FOV: 45 degrees. 2352 x 1568 pixels
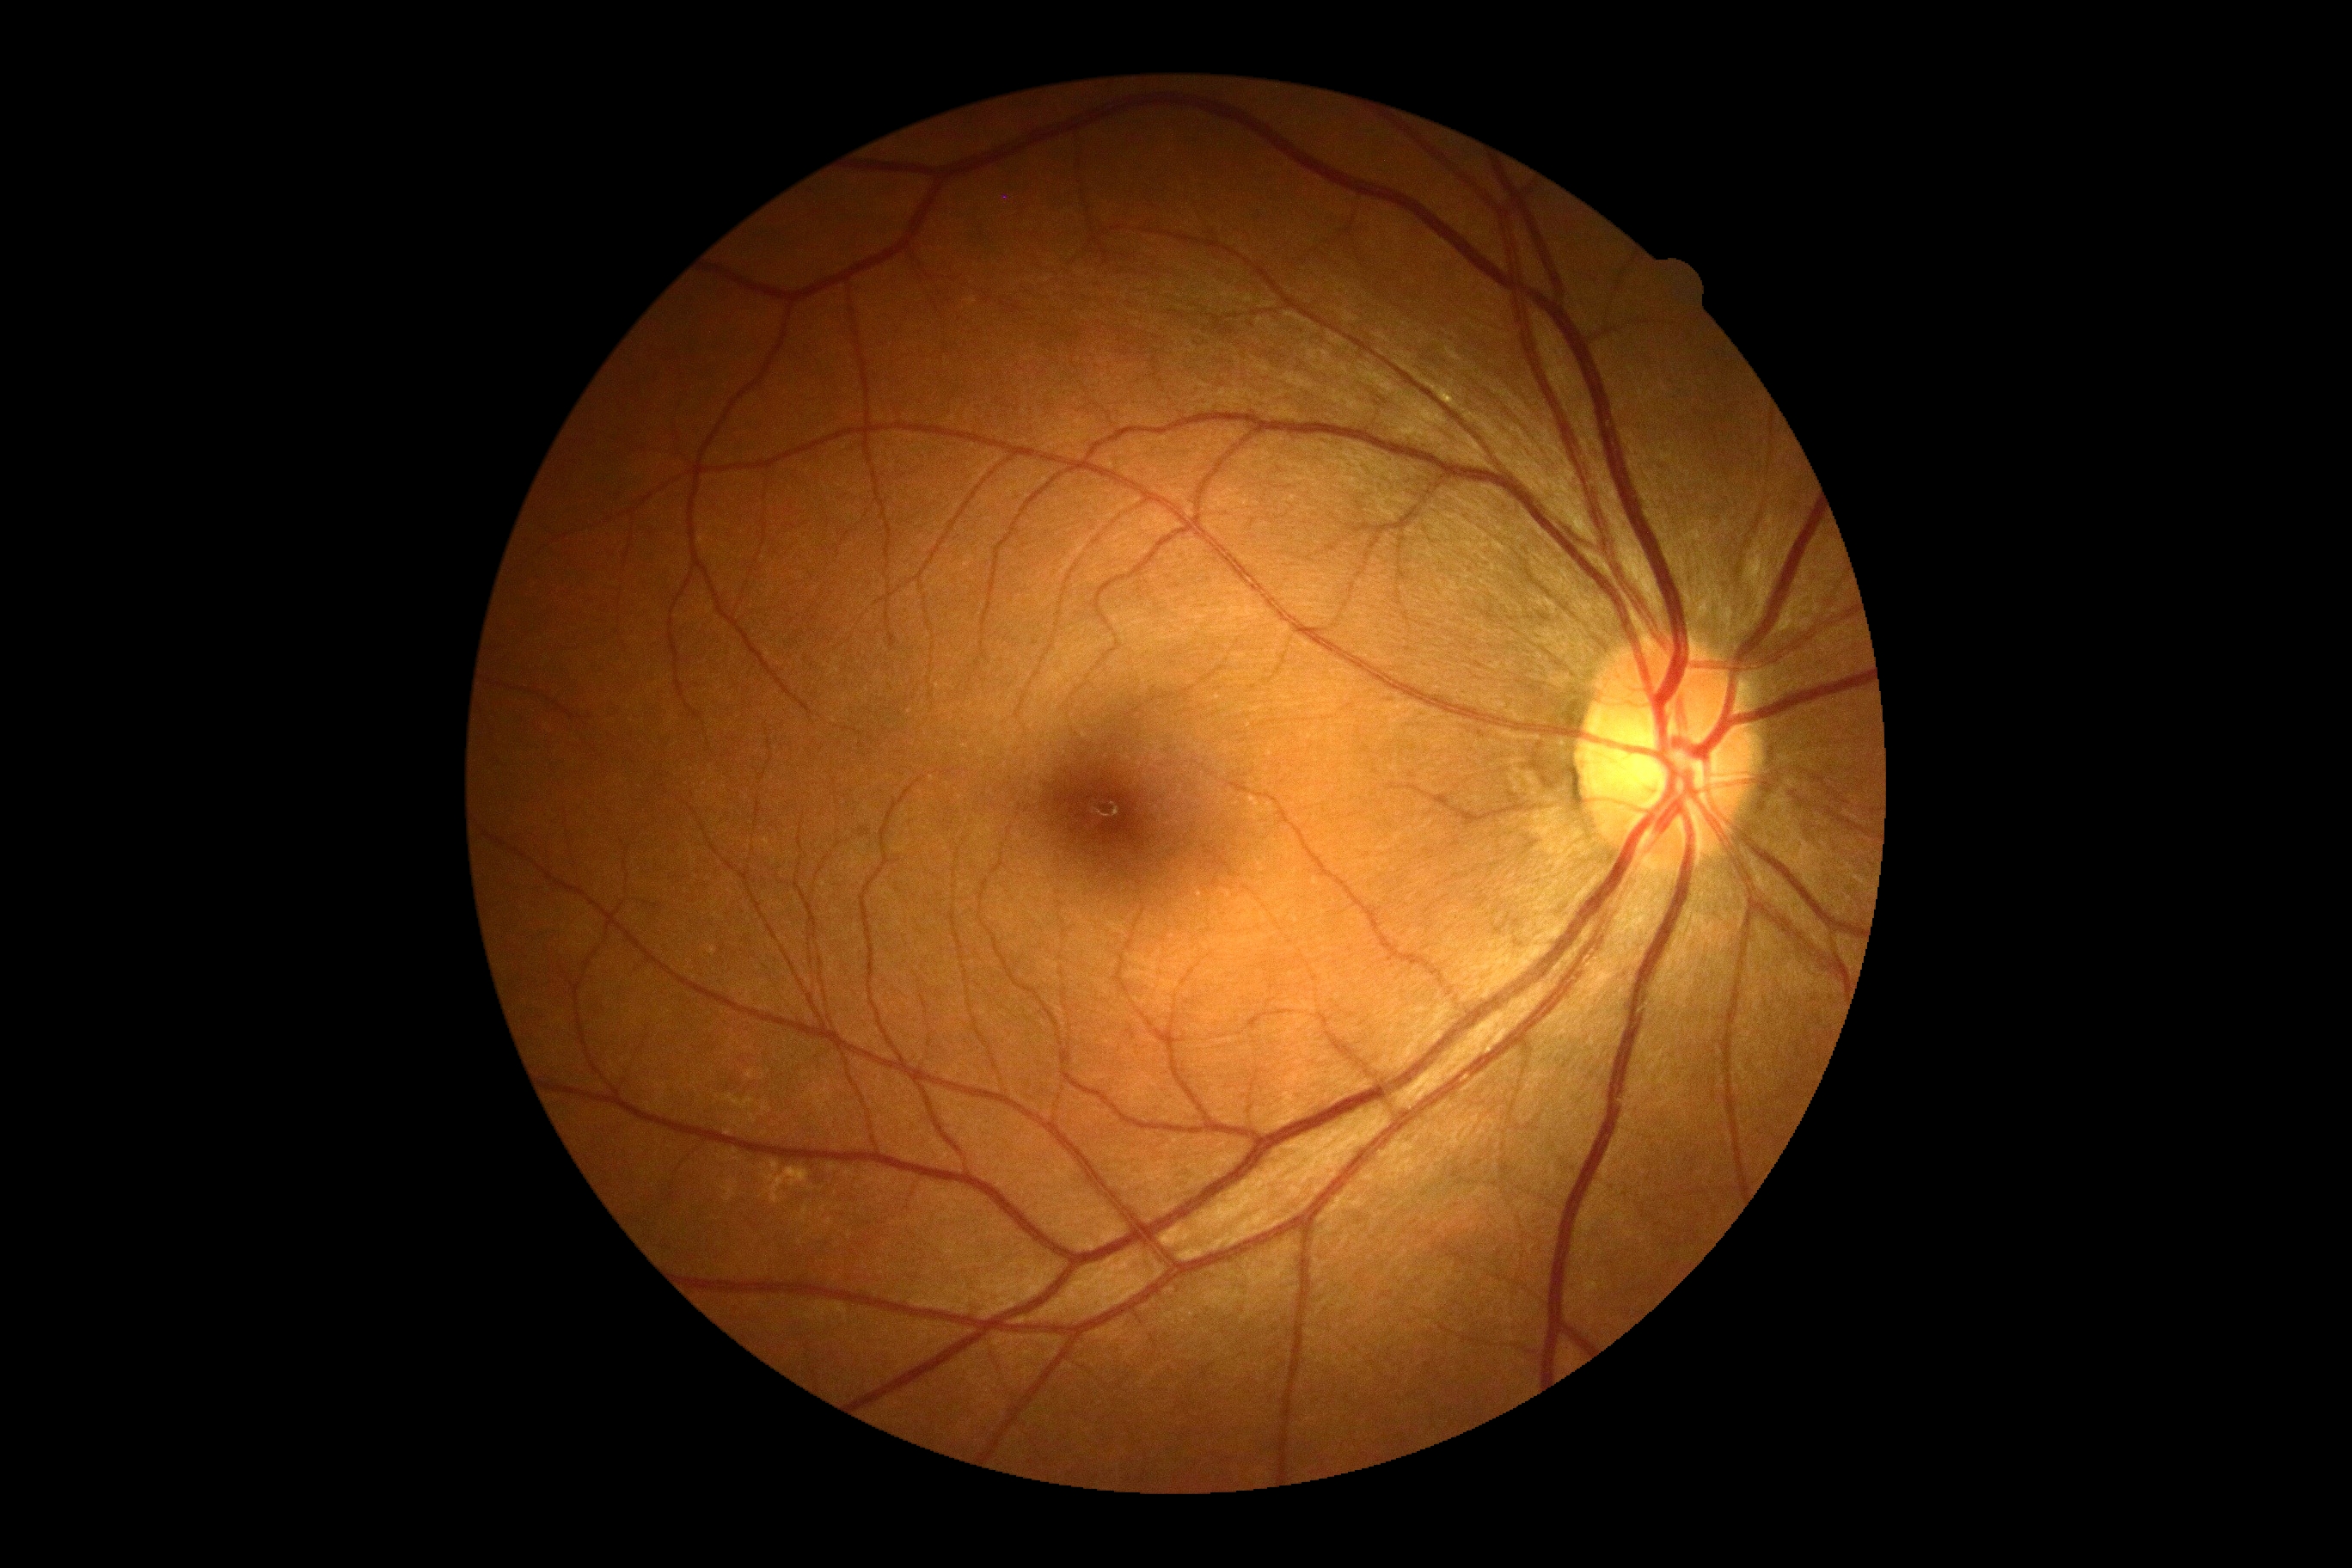 DR severity = grade 0 (no apparent retinopathy).